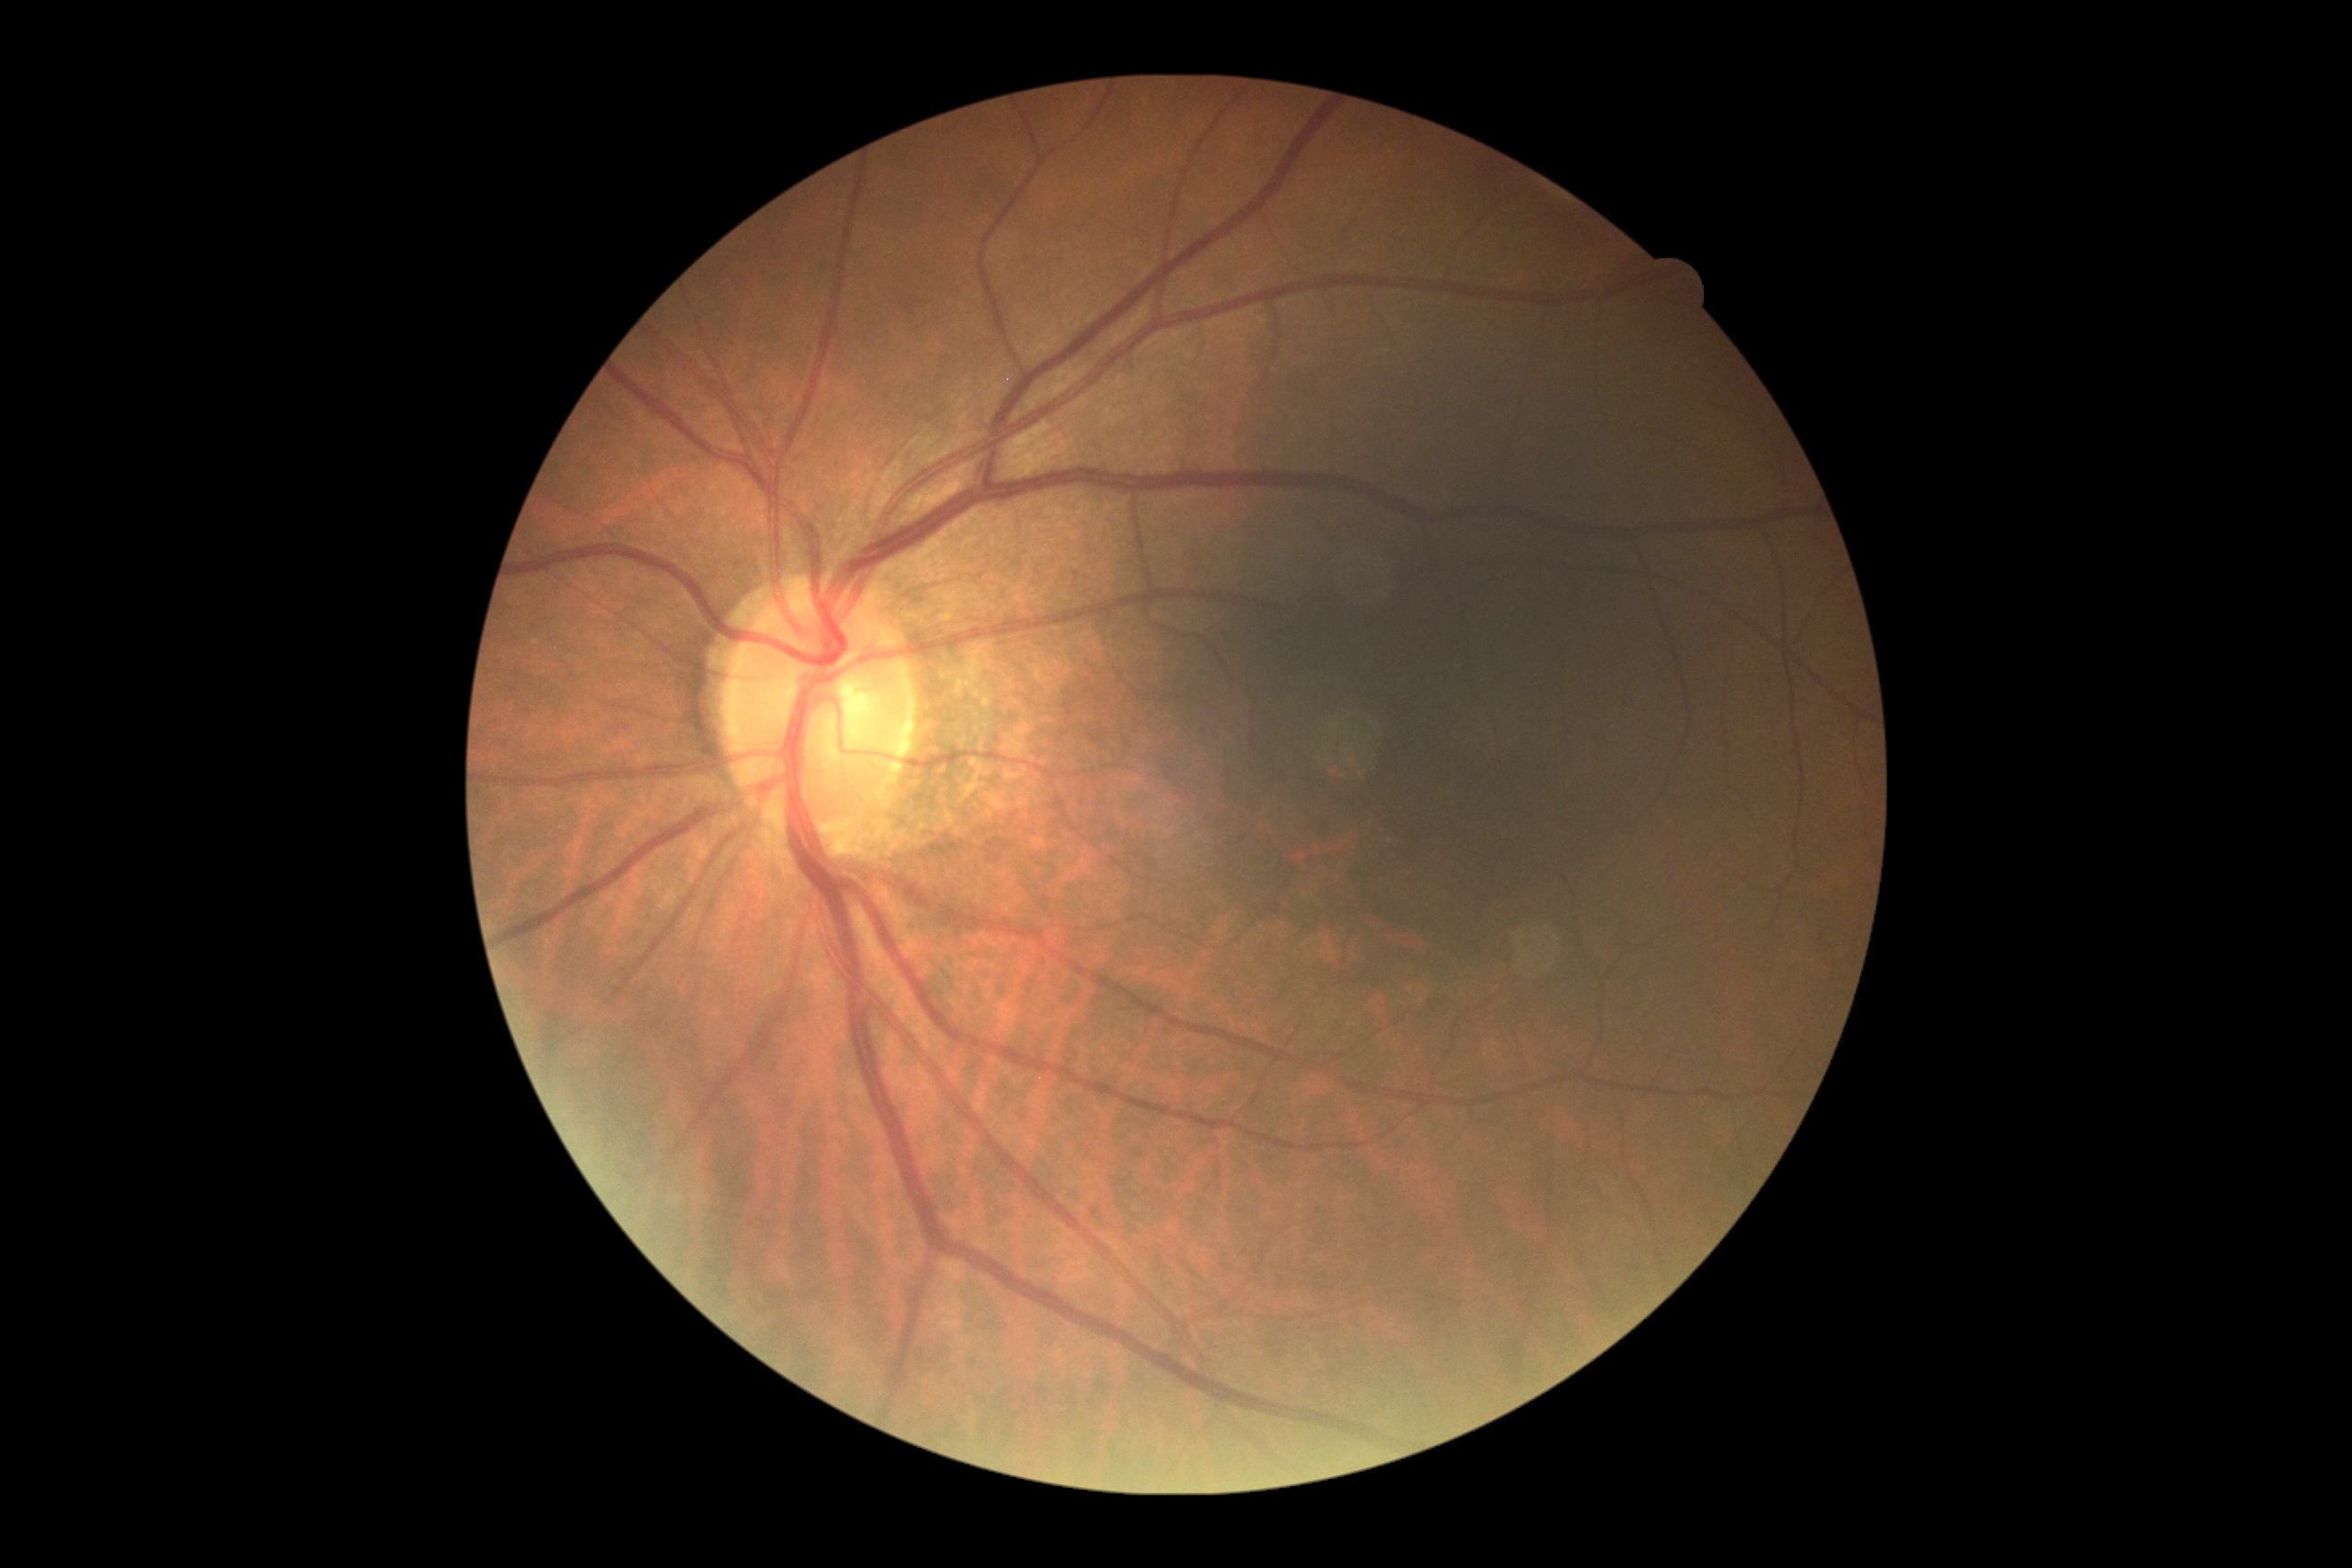 DR grade is 0 — no visible signs of diabetic retinopathy.